Nonmydriatic.
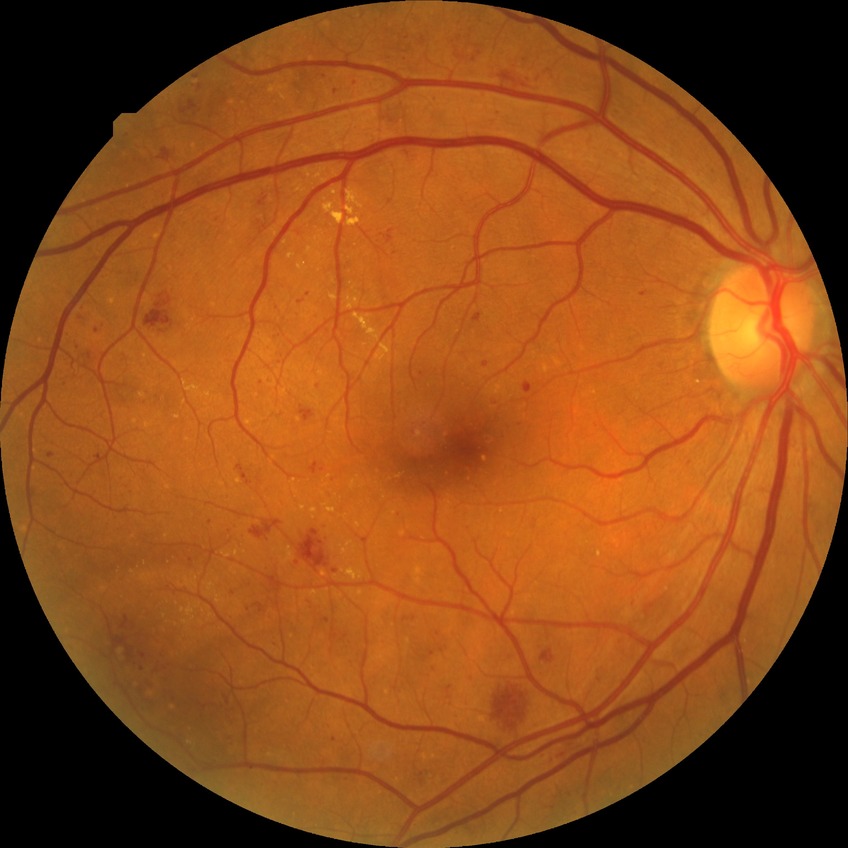

Findings:
* DR class — non-proliferative diabetic retinopathy
* Davis grade — PPDR